Wide-field contact fundus photograph of an infant:
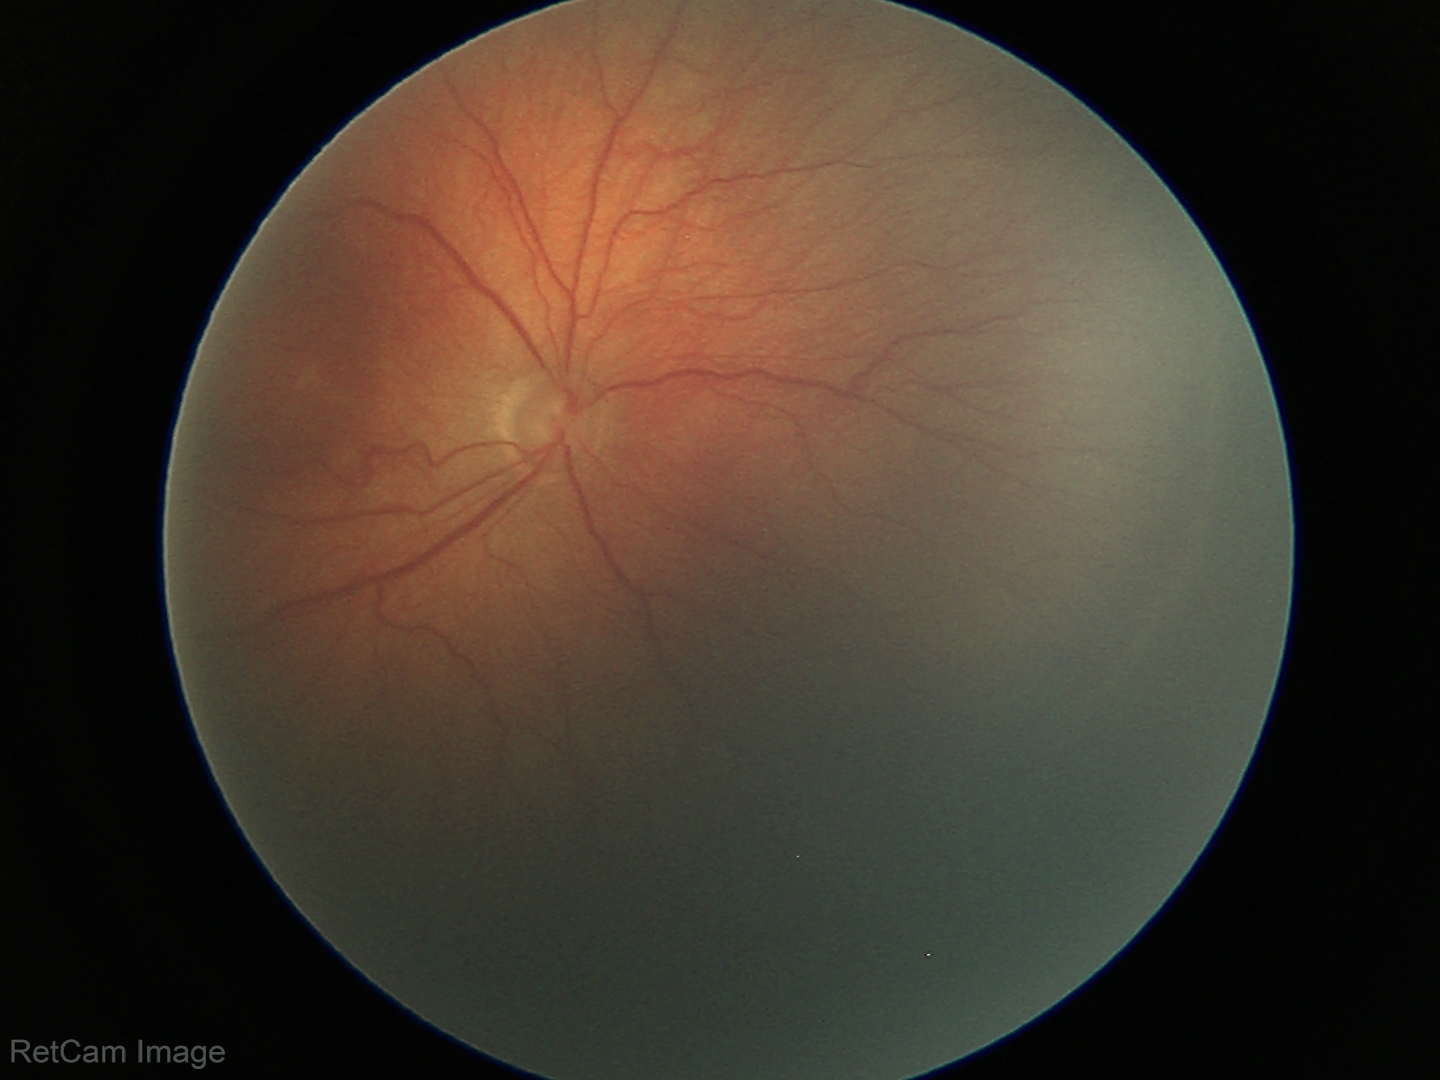

Impression: retinopathy of prematurity stage 3 | plus disease: absent.